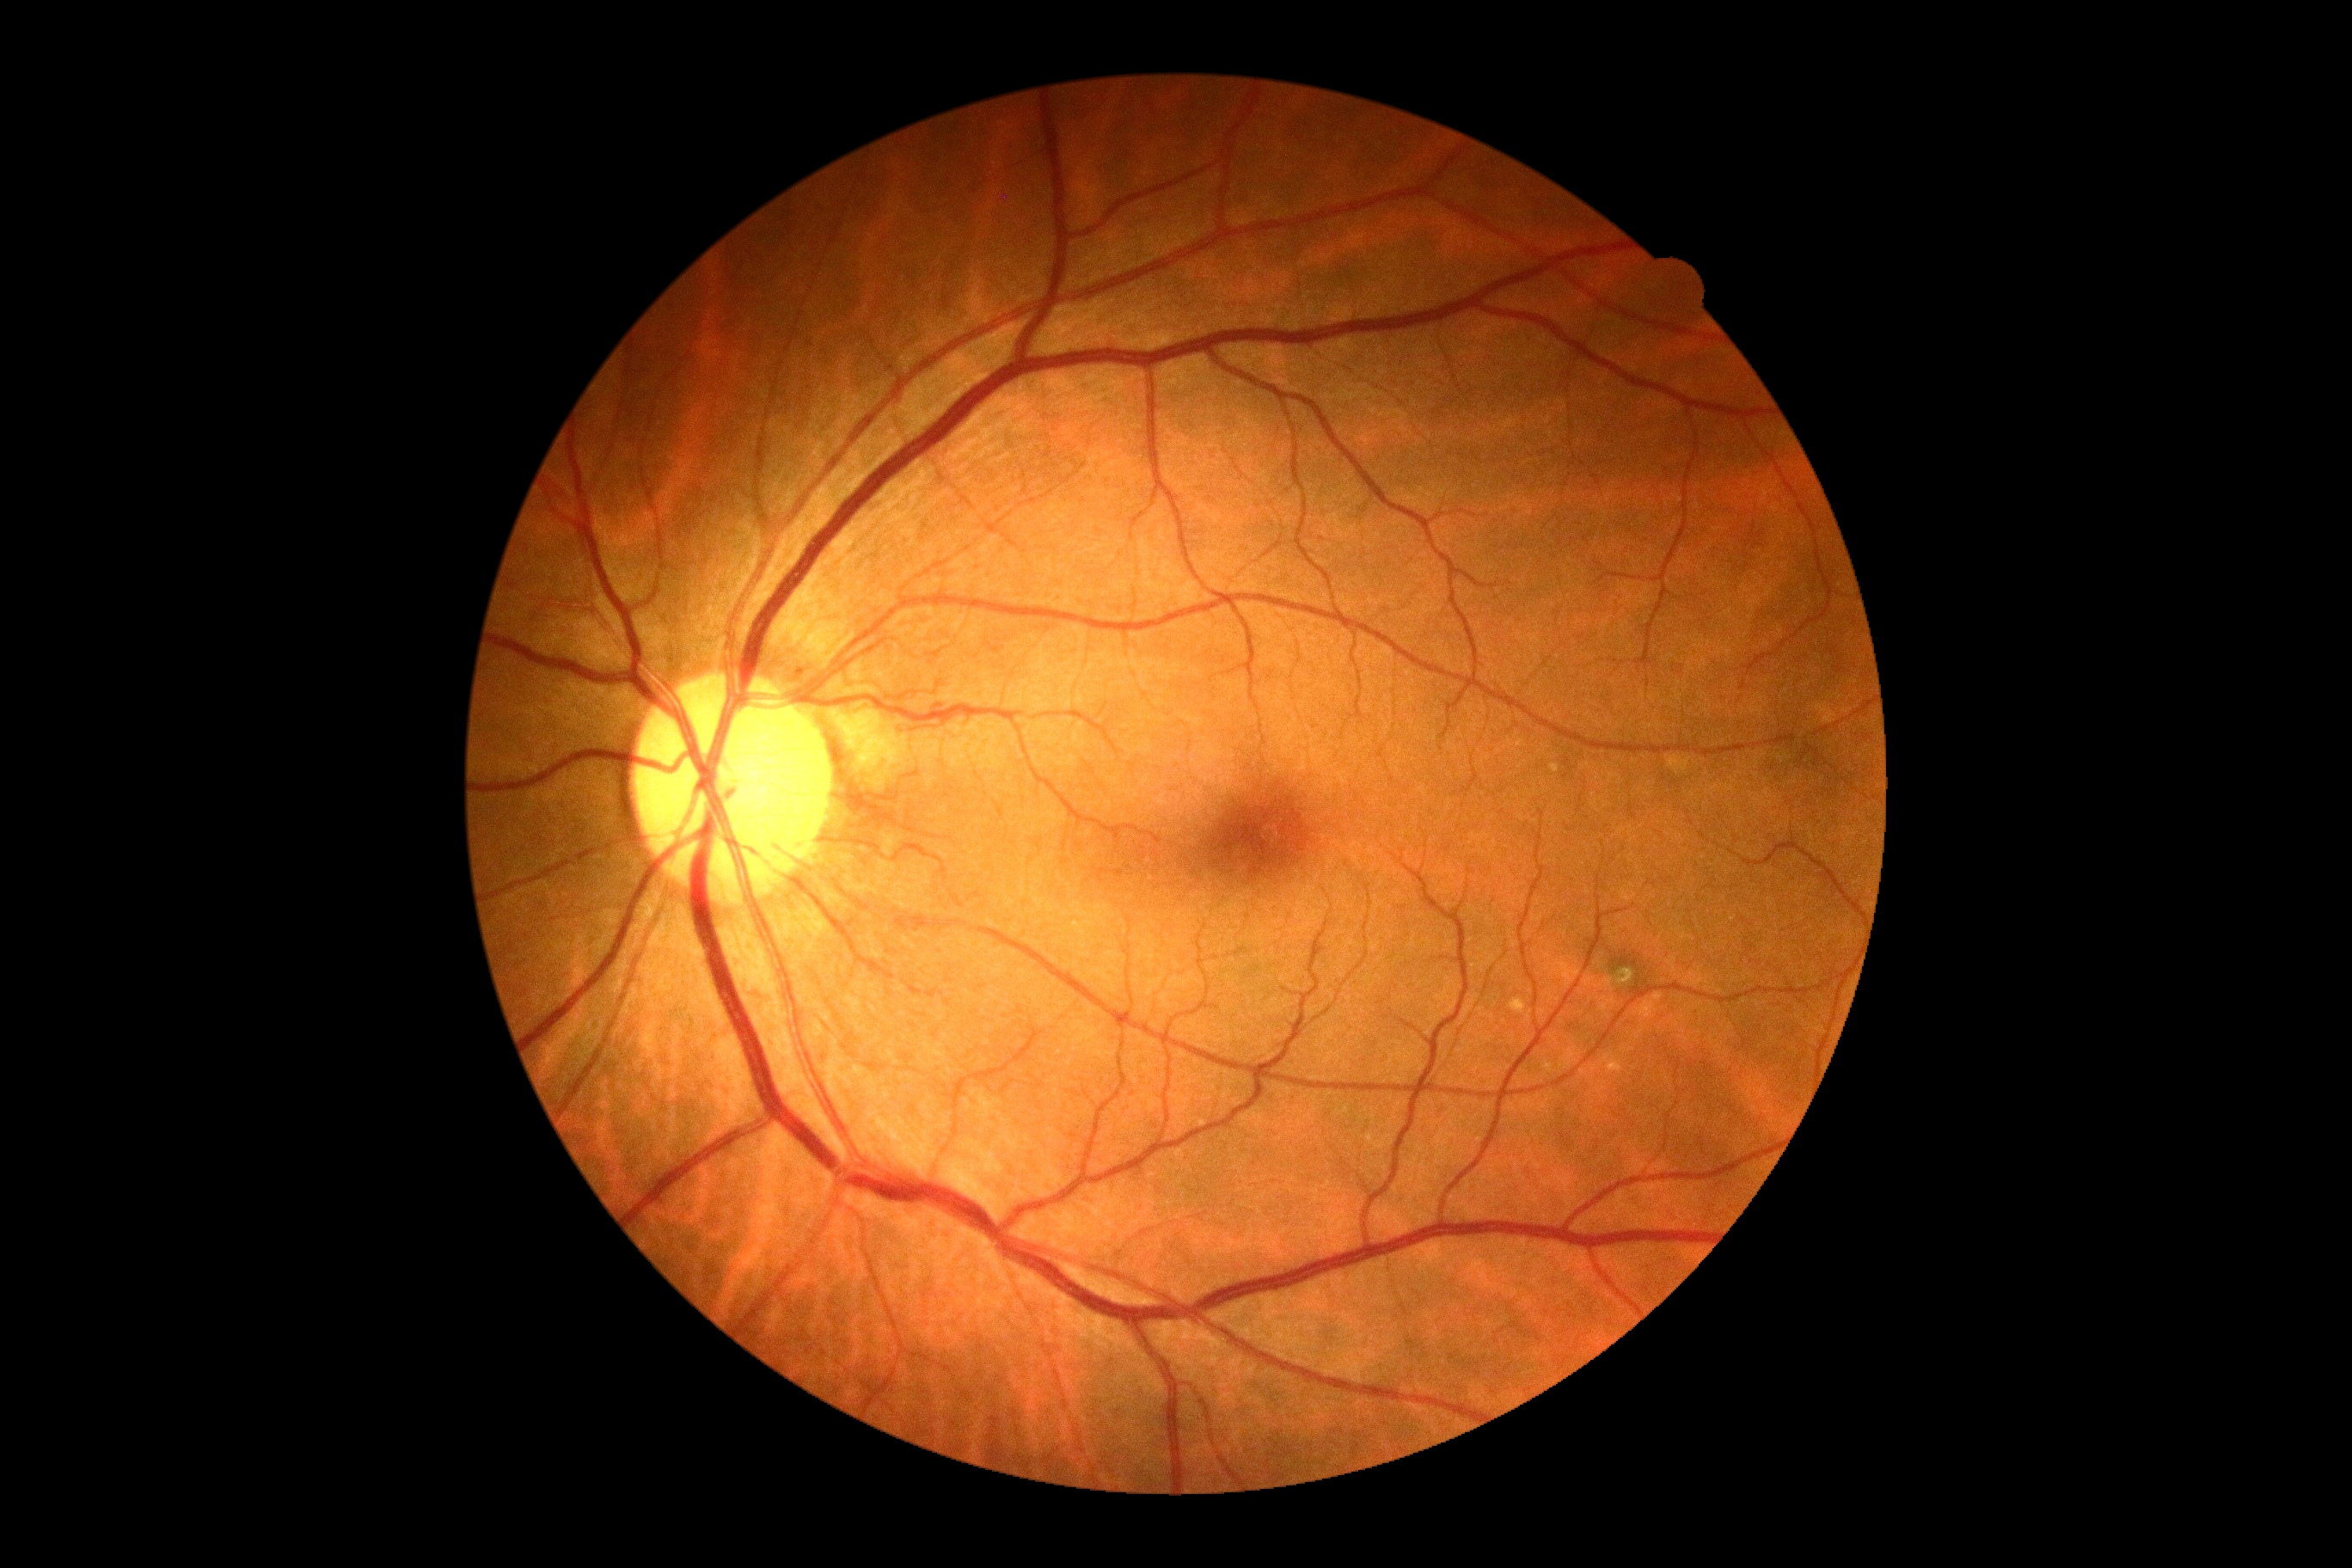

  dr_grade: 0 (no apparent retinopathy)